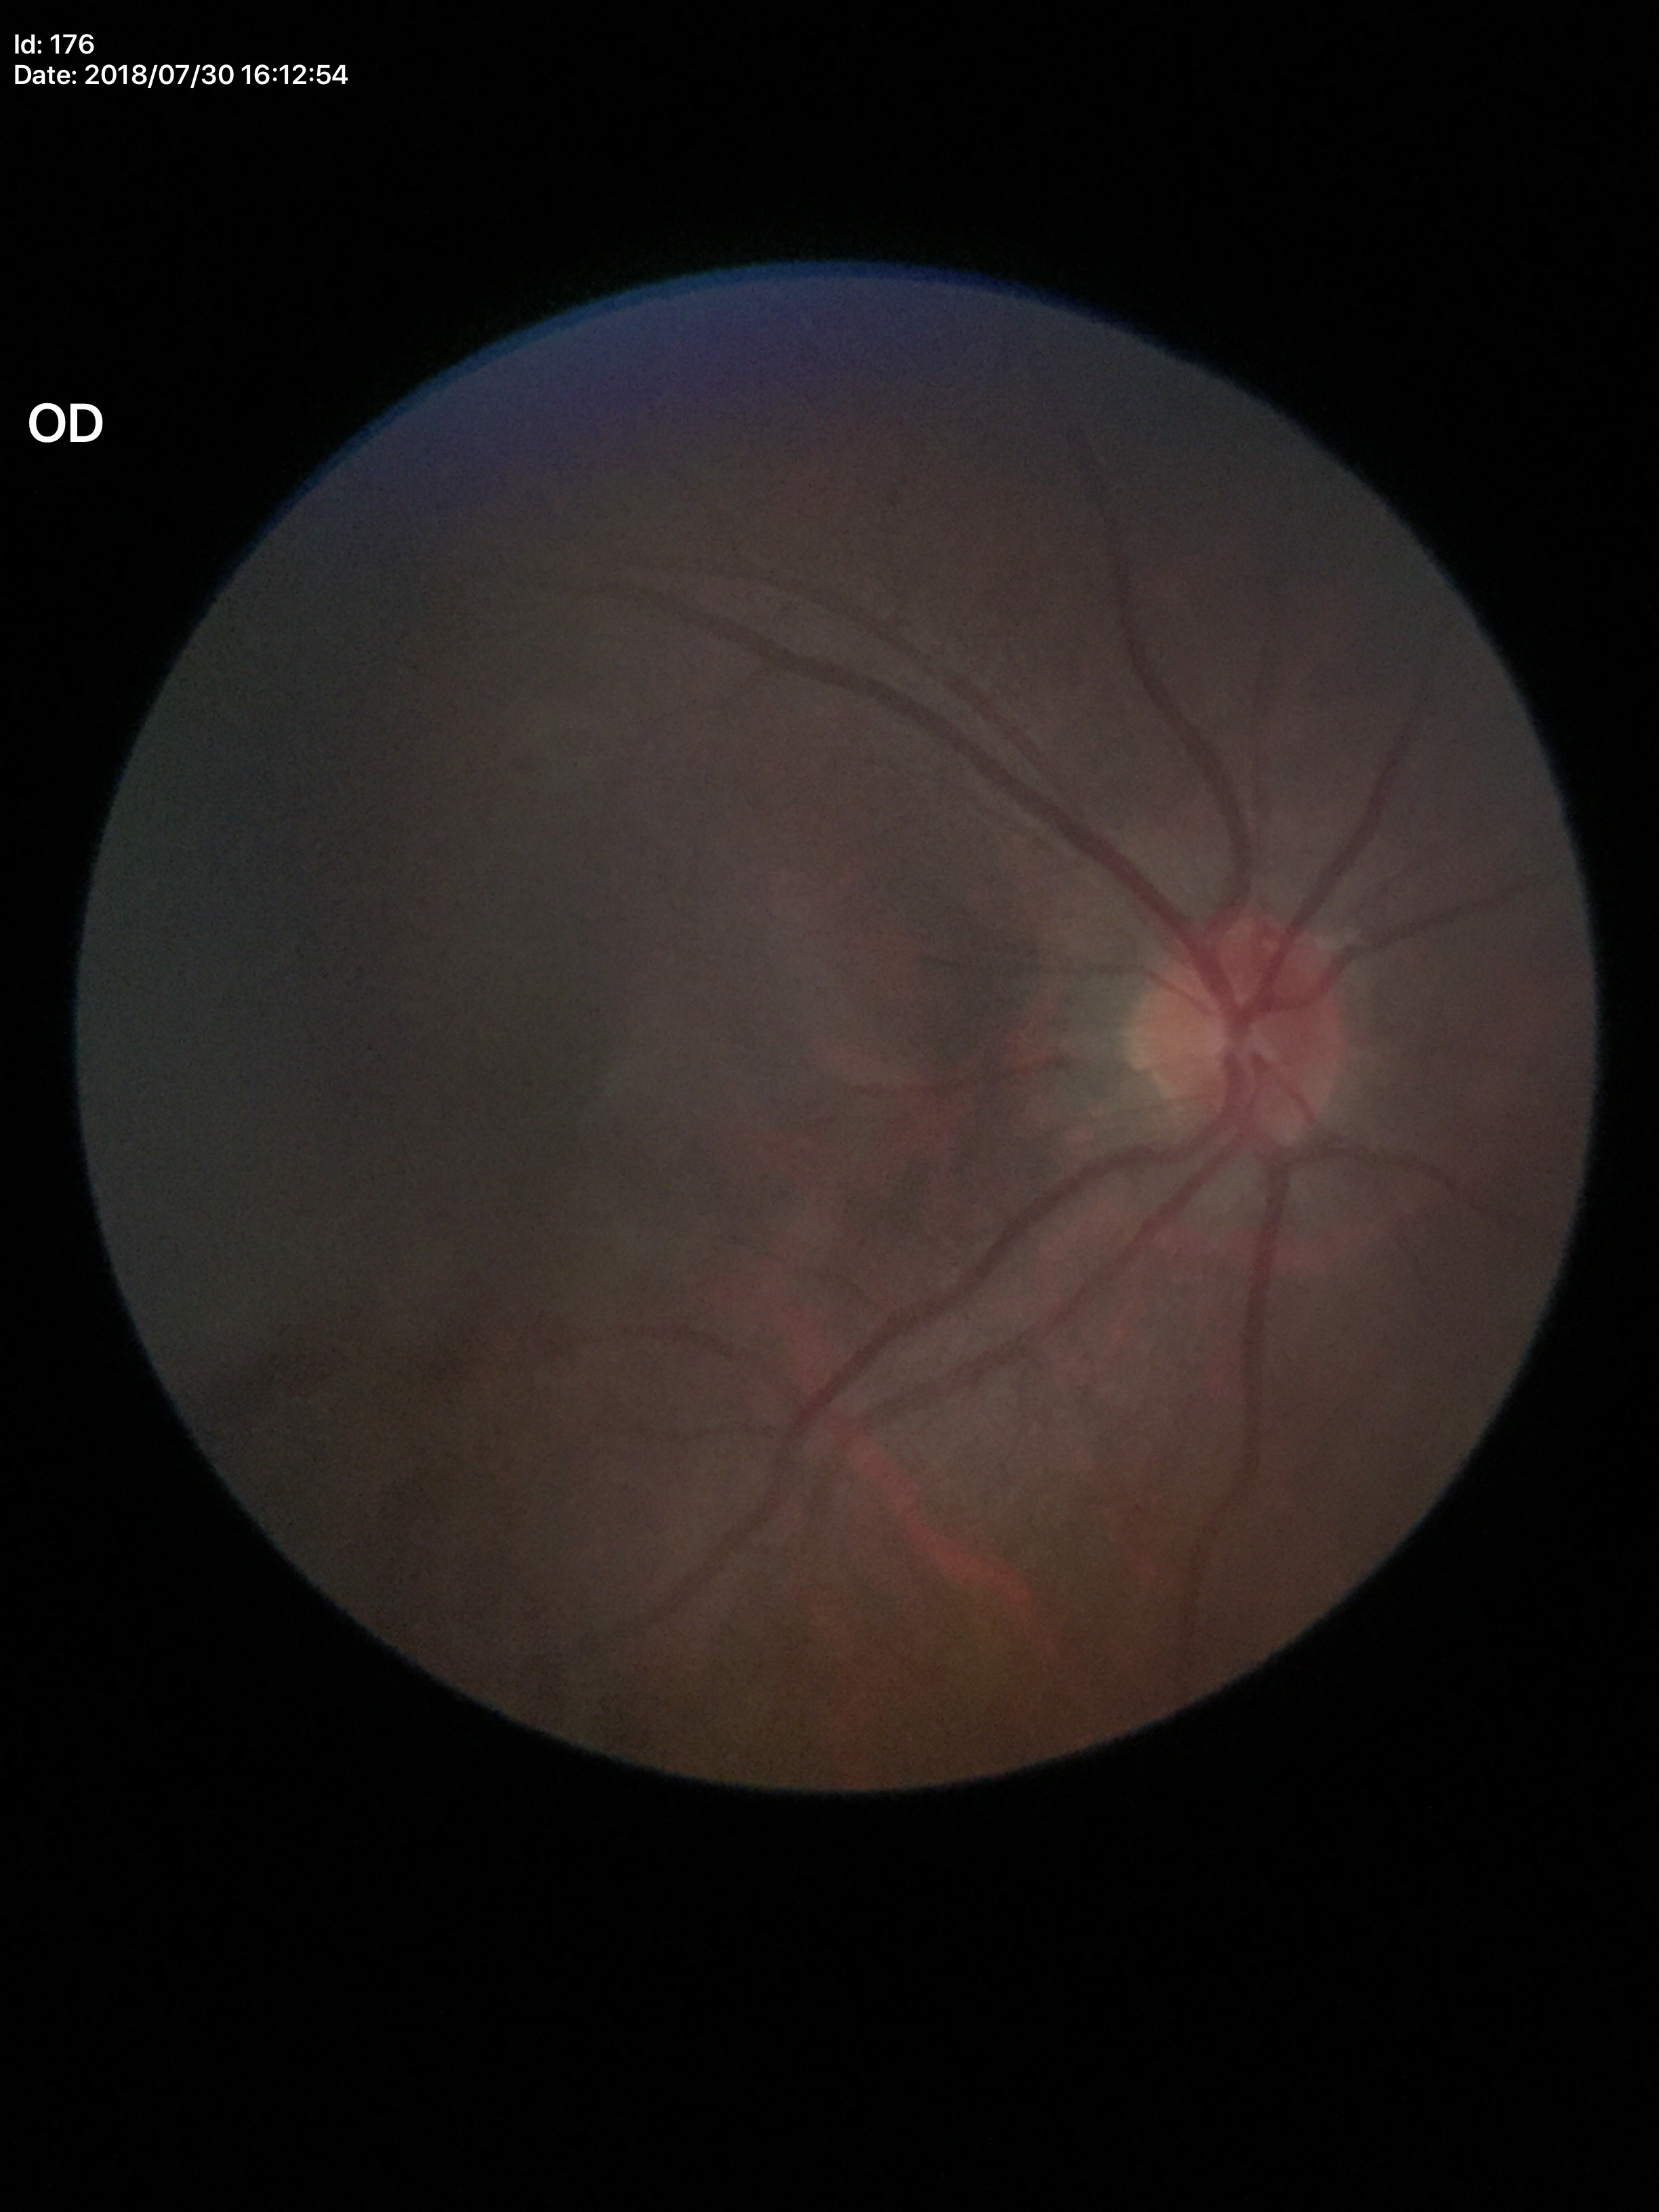

Glaucoma evaluation: not suspect (all 5 graders called normal). Vertical C/D ratio (VCDR): 0.39.